Pediatric retinal photograph (wide-field)
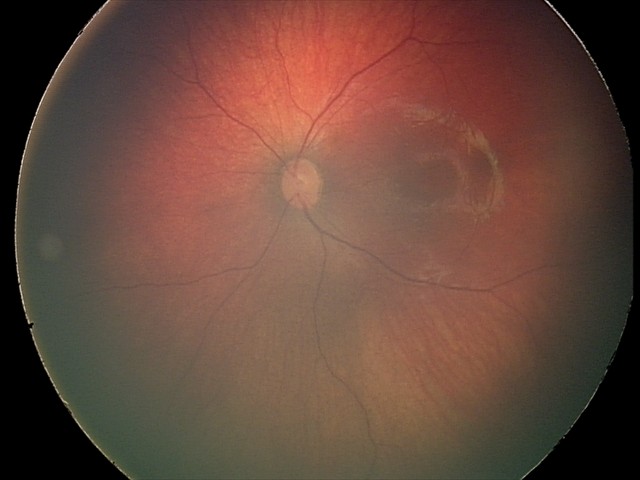 Screening diagnosis = retinal hemorrhages.